NIDEK AFC-230 fundus camera. 848x848px
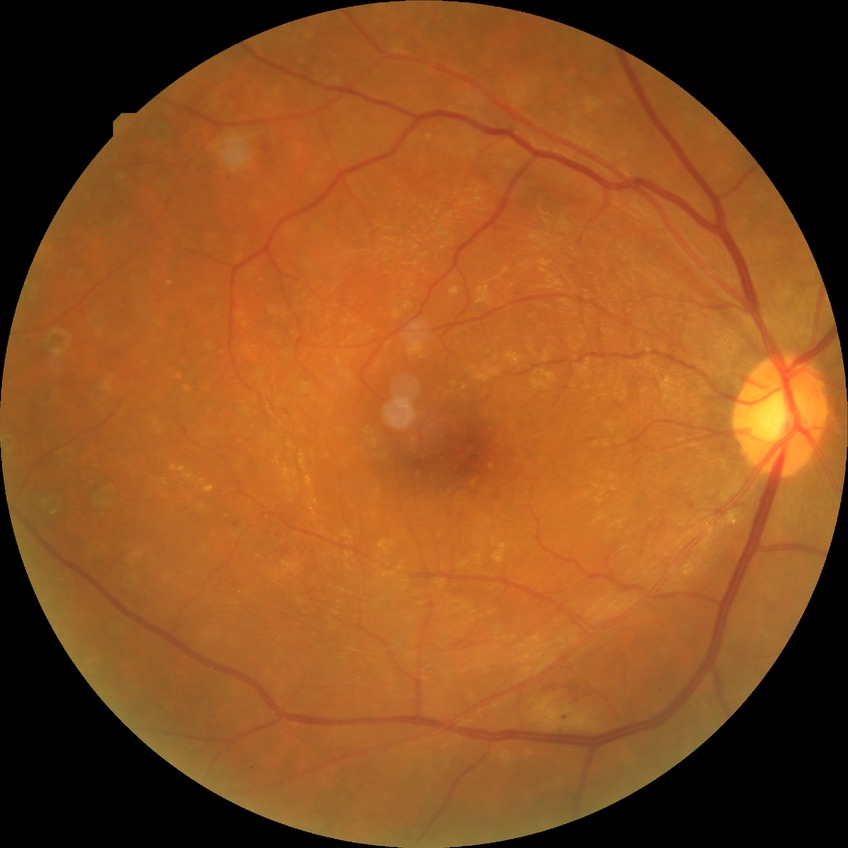

Modified Davis grading is proliferative diabetic retinopathy.